Fundus photo:
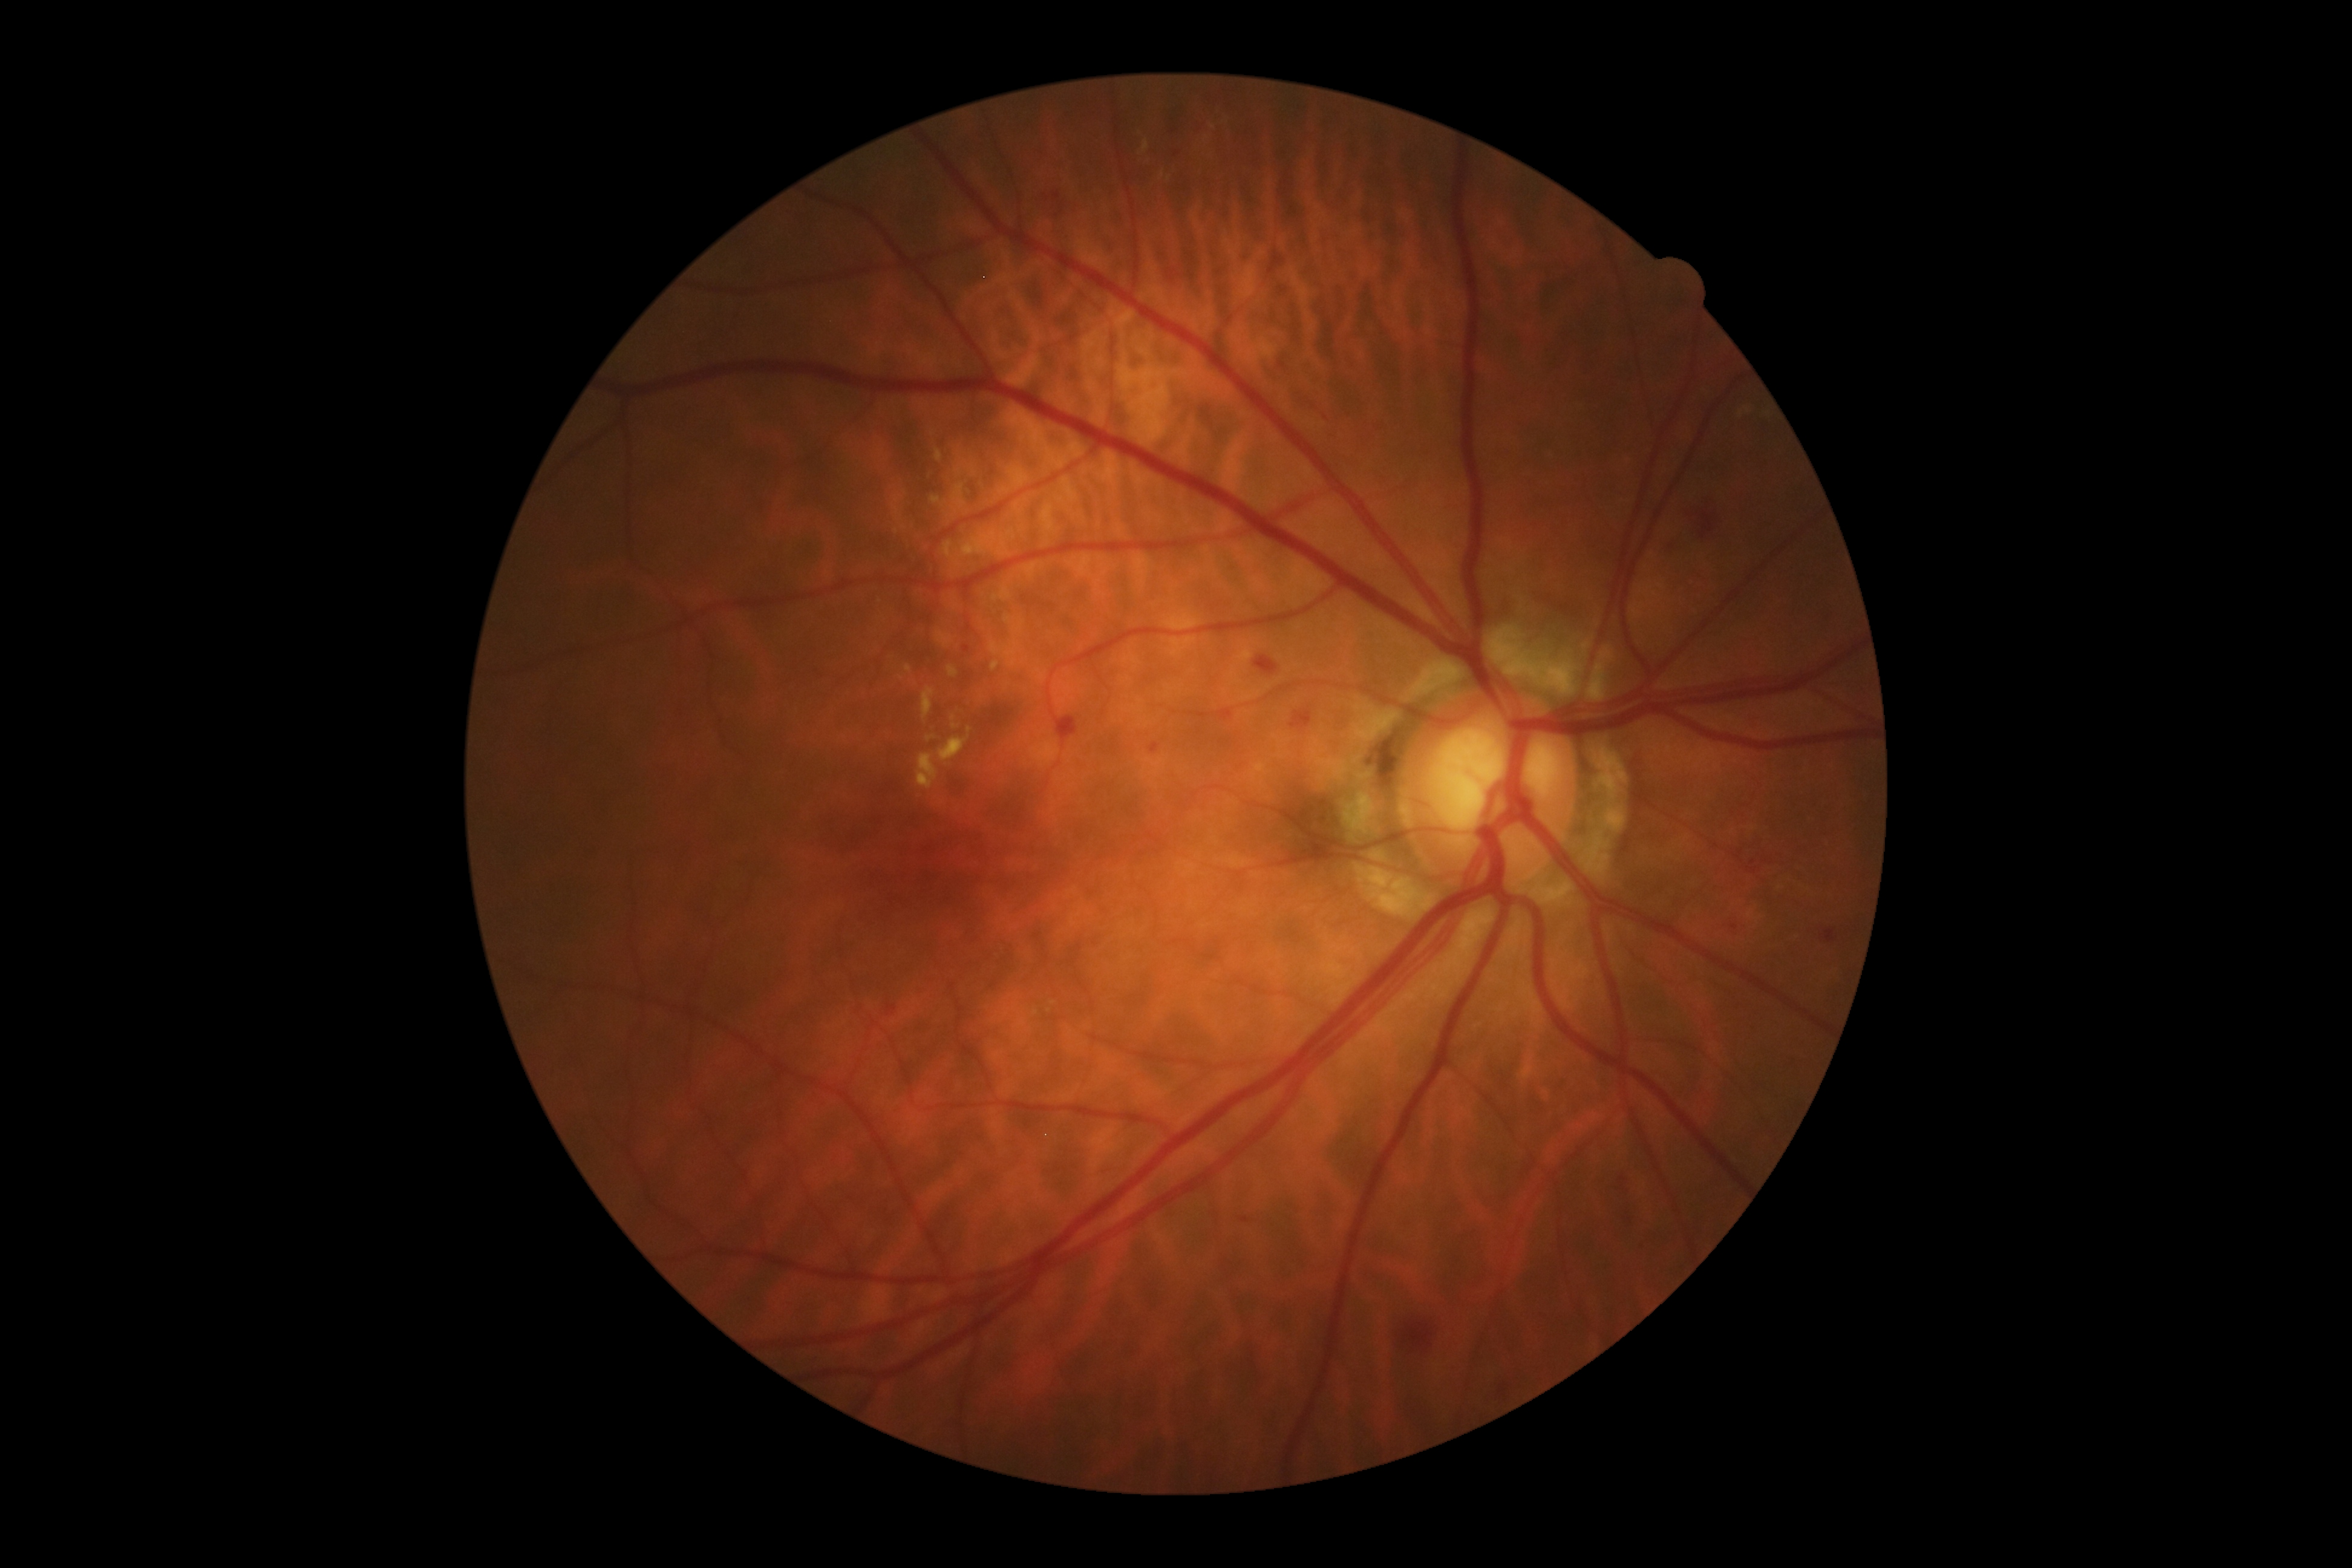
Retinopathy grade: 2 (moderate NPDR)
Selected lesions:
• hard exudates (partial): 1030,742,1058,769; 952,485,966,509; 931,498,941,504; 1014,503,1022,514; 948,666,959,678; 938,736,970,765; 936,448,942,463; 993,586,1012,602; 943,540,953,558
• Smaller hard exudates around Point(1026, 660); Point(969, 730); Point(974, 472); Point(955, 727); Point(954, 719)